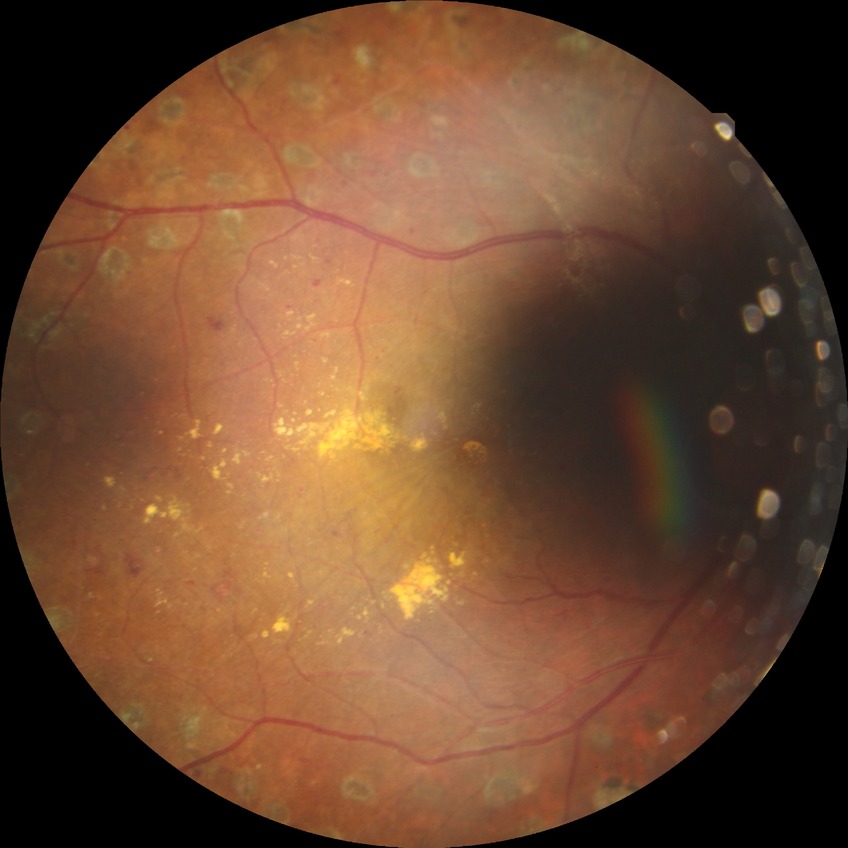

diabetic retinopathy (DR): proliferative diabetic retinopathy (PDR).